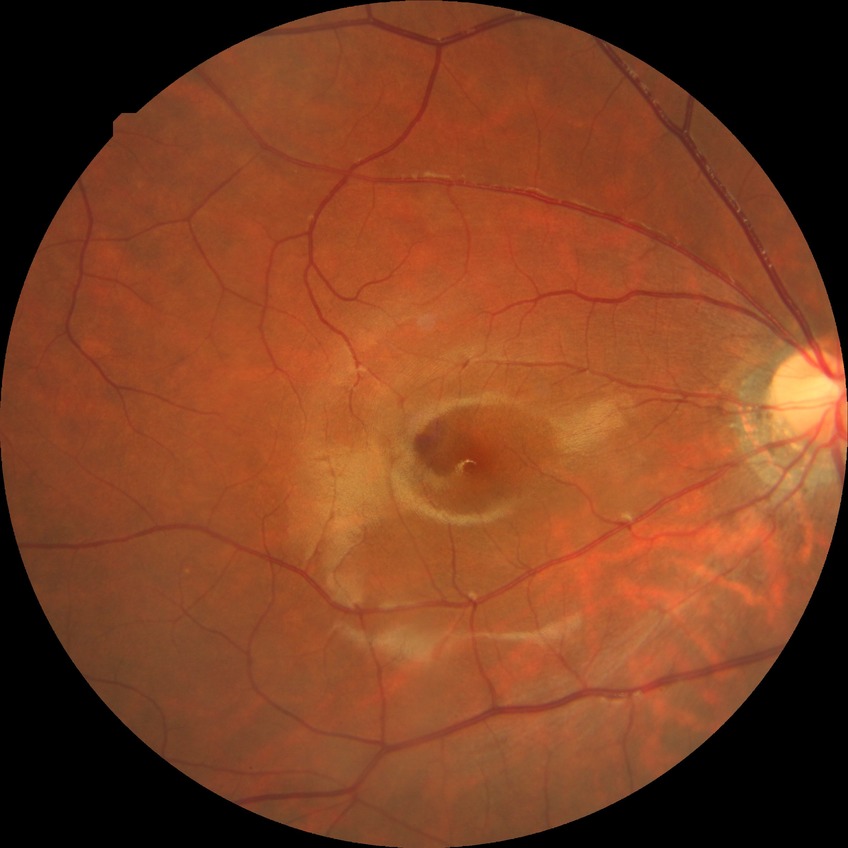

Diabetic retinopathy (DR): simple diabetic retinopathy (SDR).